Graded on the modified Davis scale; camera: NIDEK AFC-230; without pupil dilation: 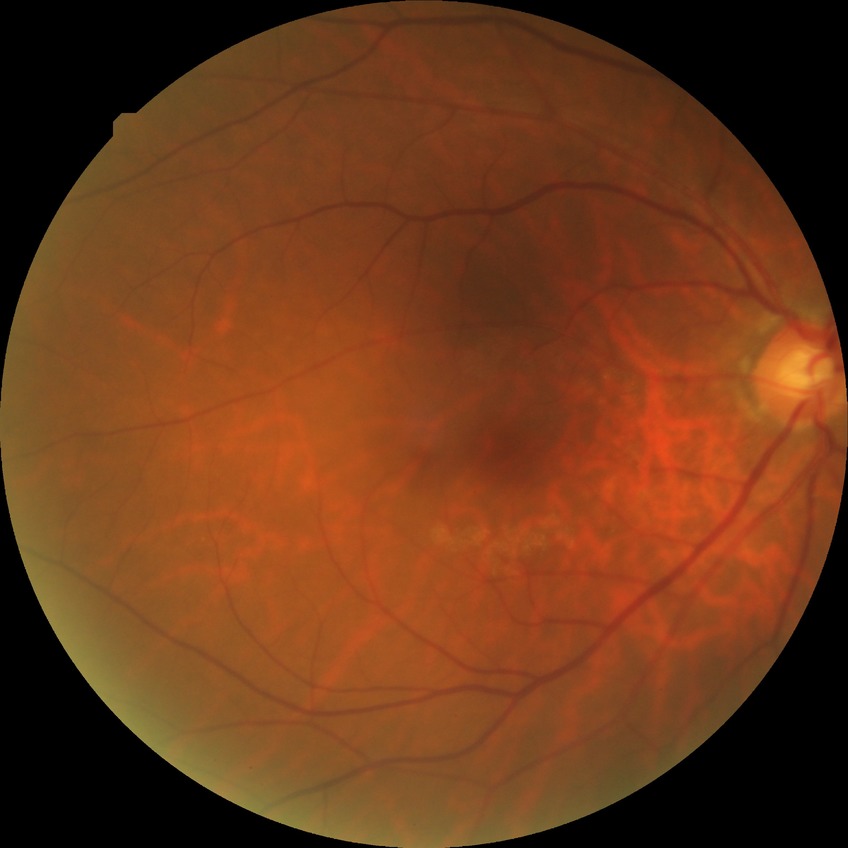 Diabetic retinopathy (DR): NDR (no diabetic retinopathy).